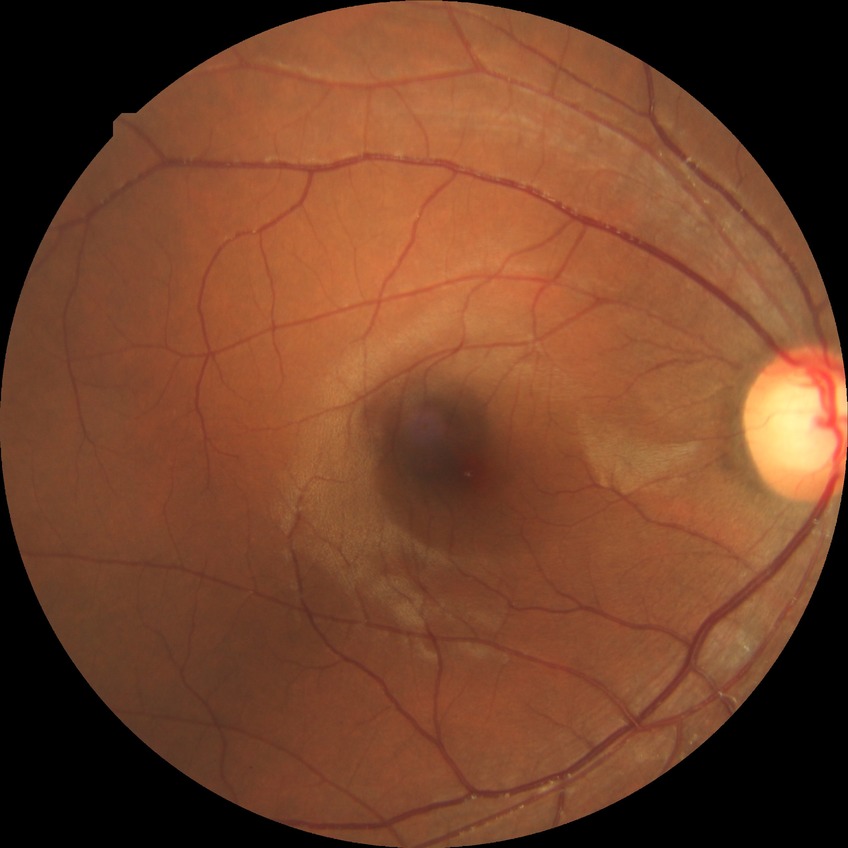

Davis stage: NDR.
No DR findings.